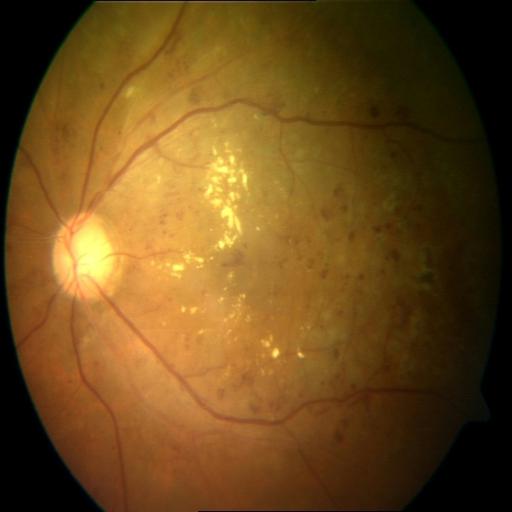
Impression (2):
- exudation (EDN)
- hemorrhagic retinopathy (HR)